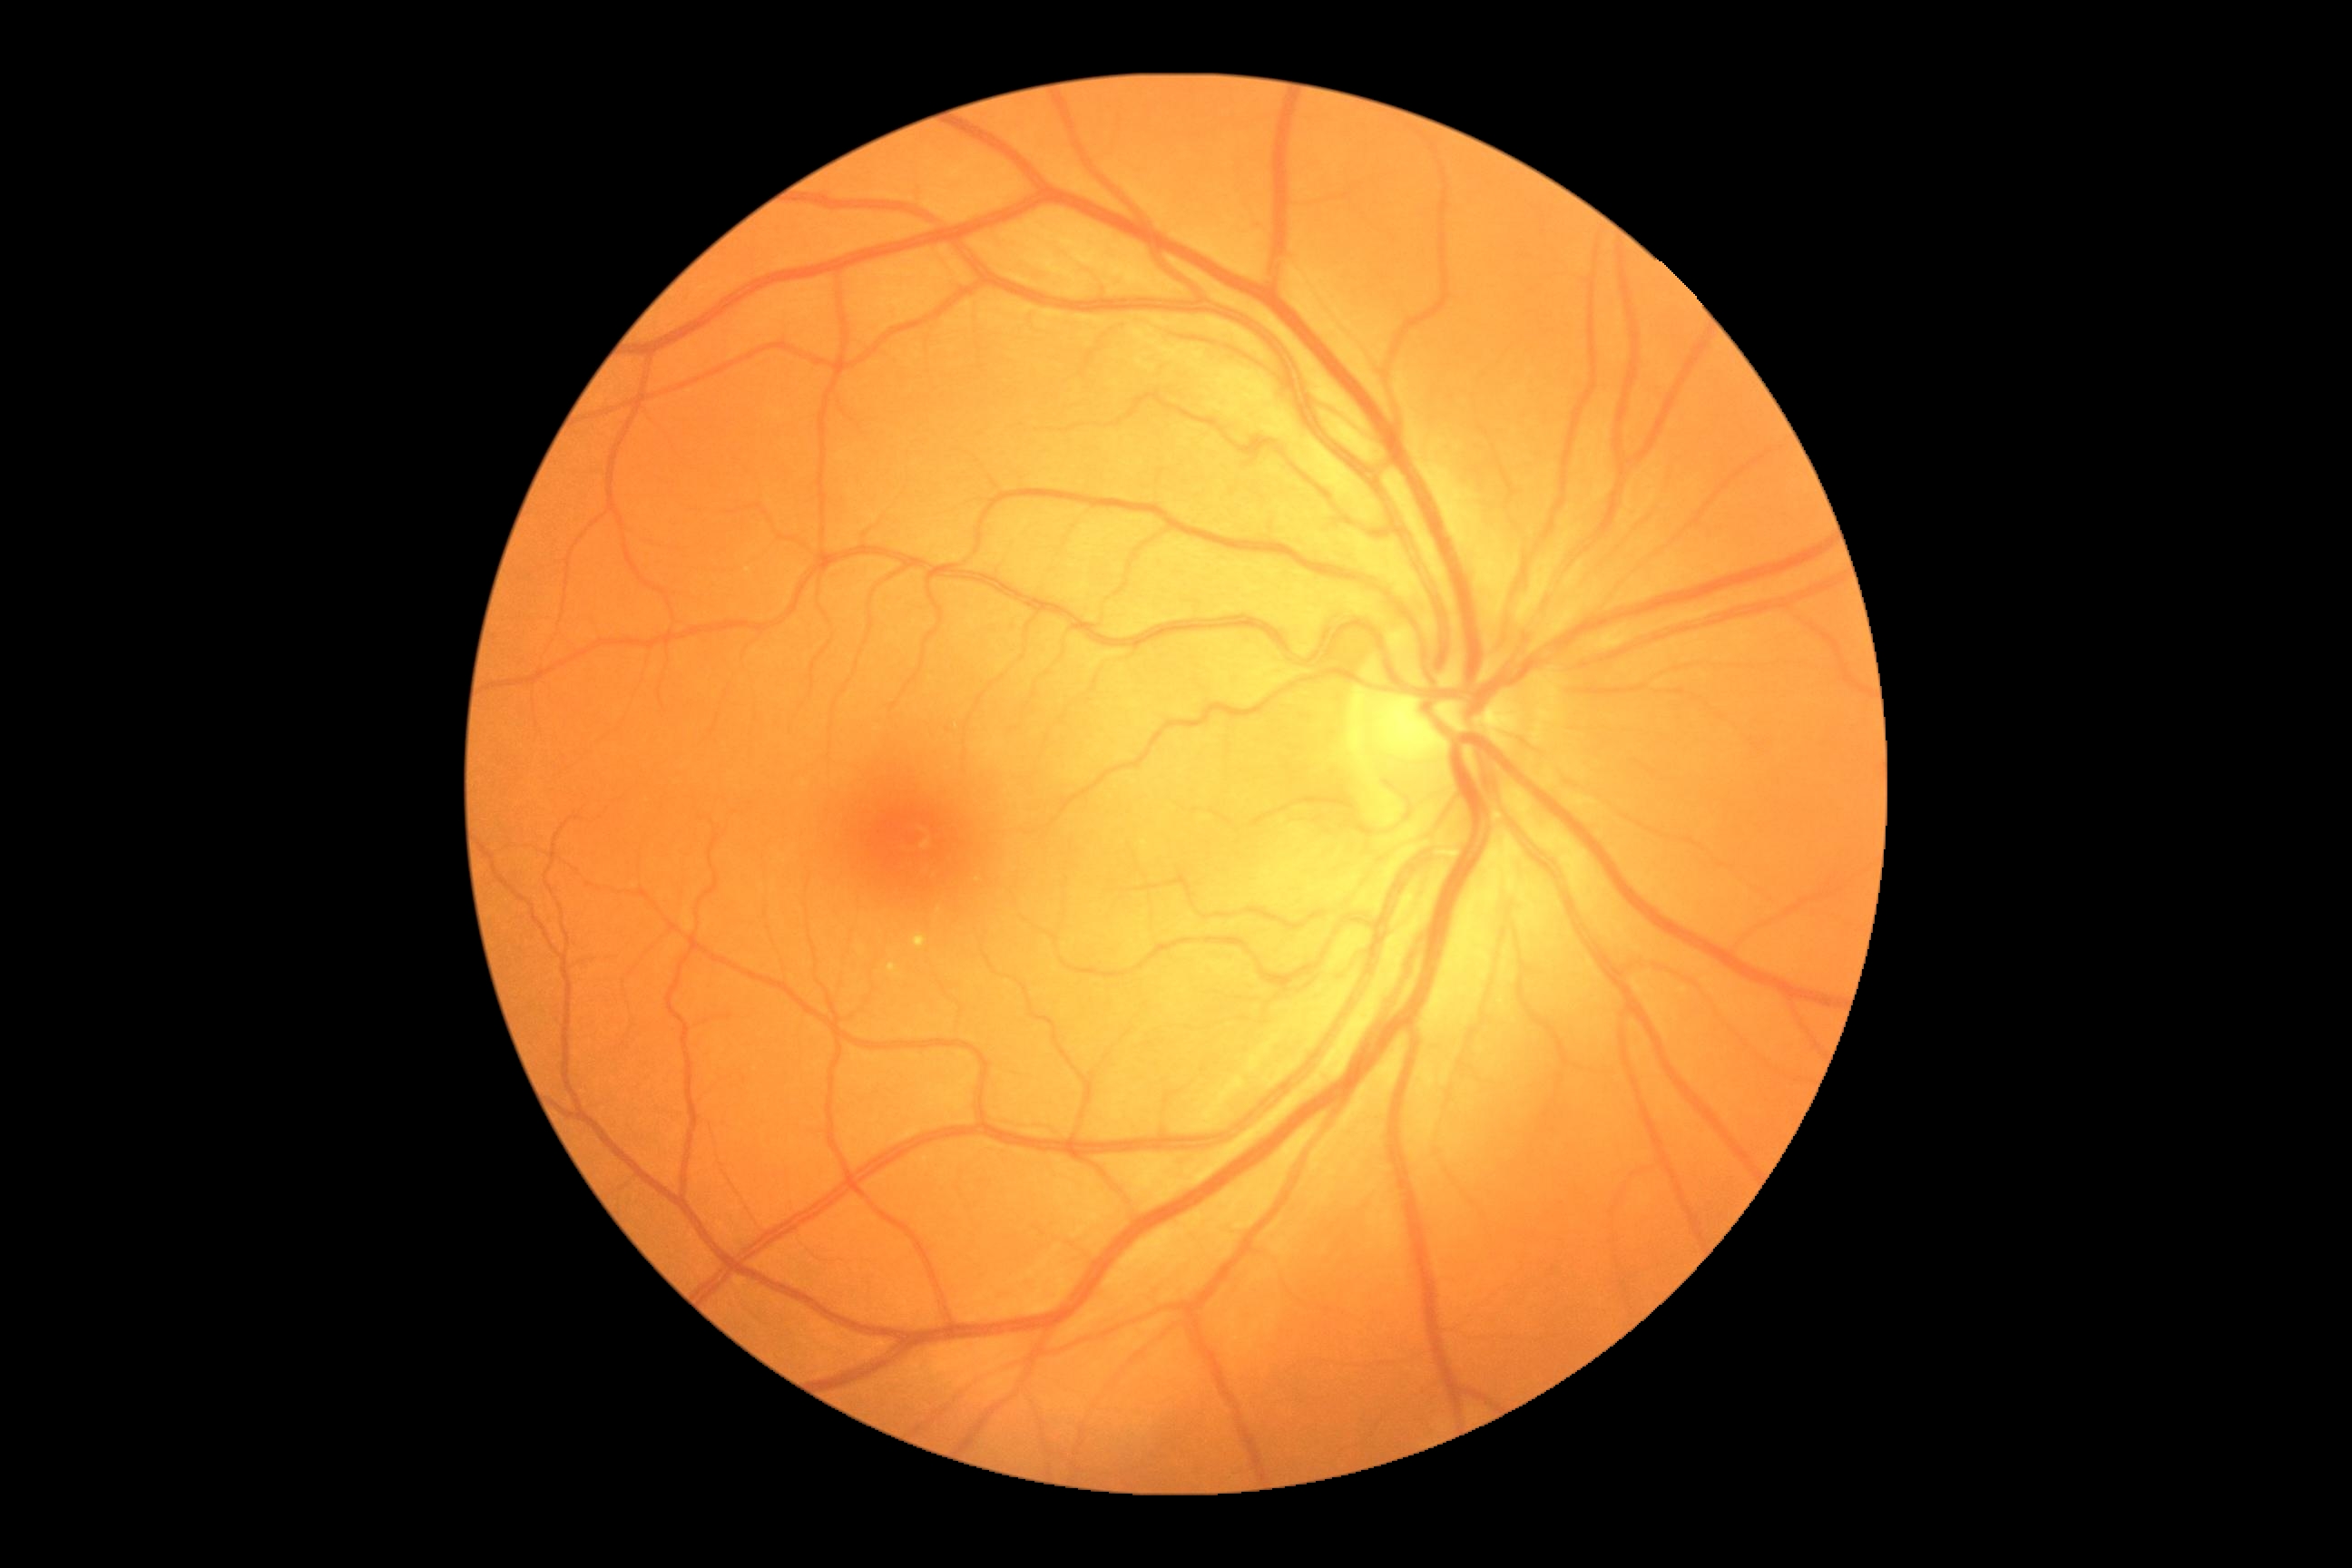 DR class: non-proliferative diabetic retinopathy; DR severity: moderate non-proliferative diabetic retinopathy (grade 2).